Kowa VX-10α. 2361 by 1568 pixels — 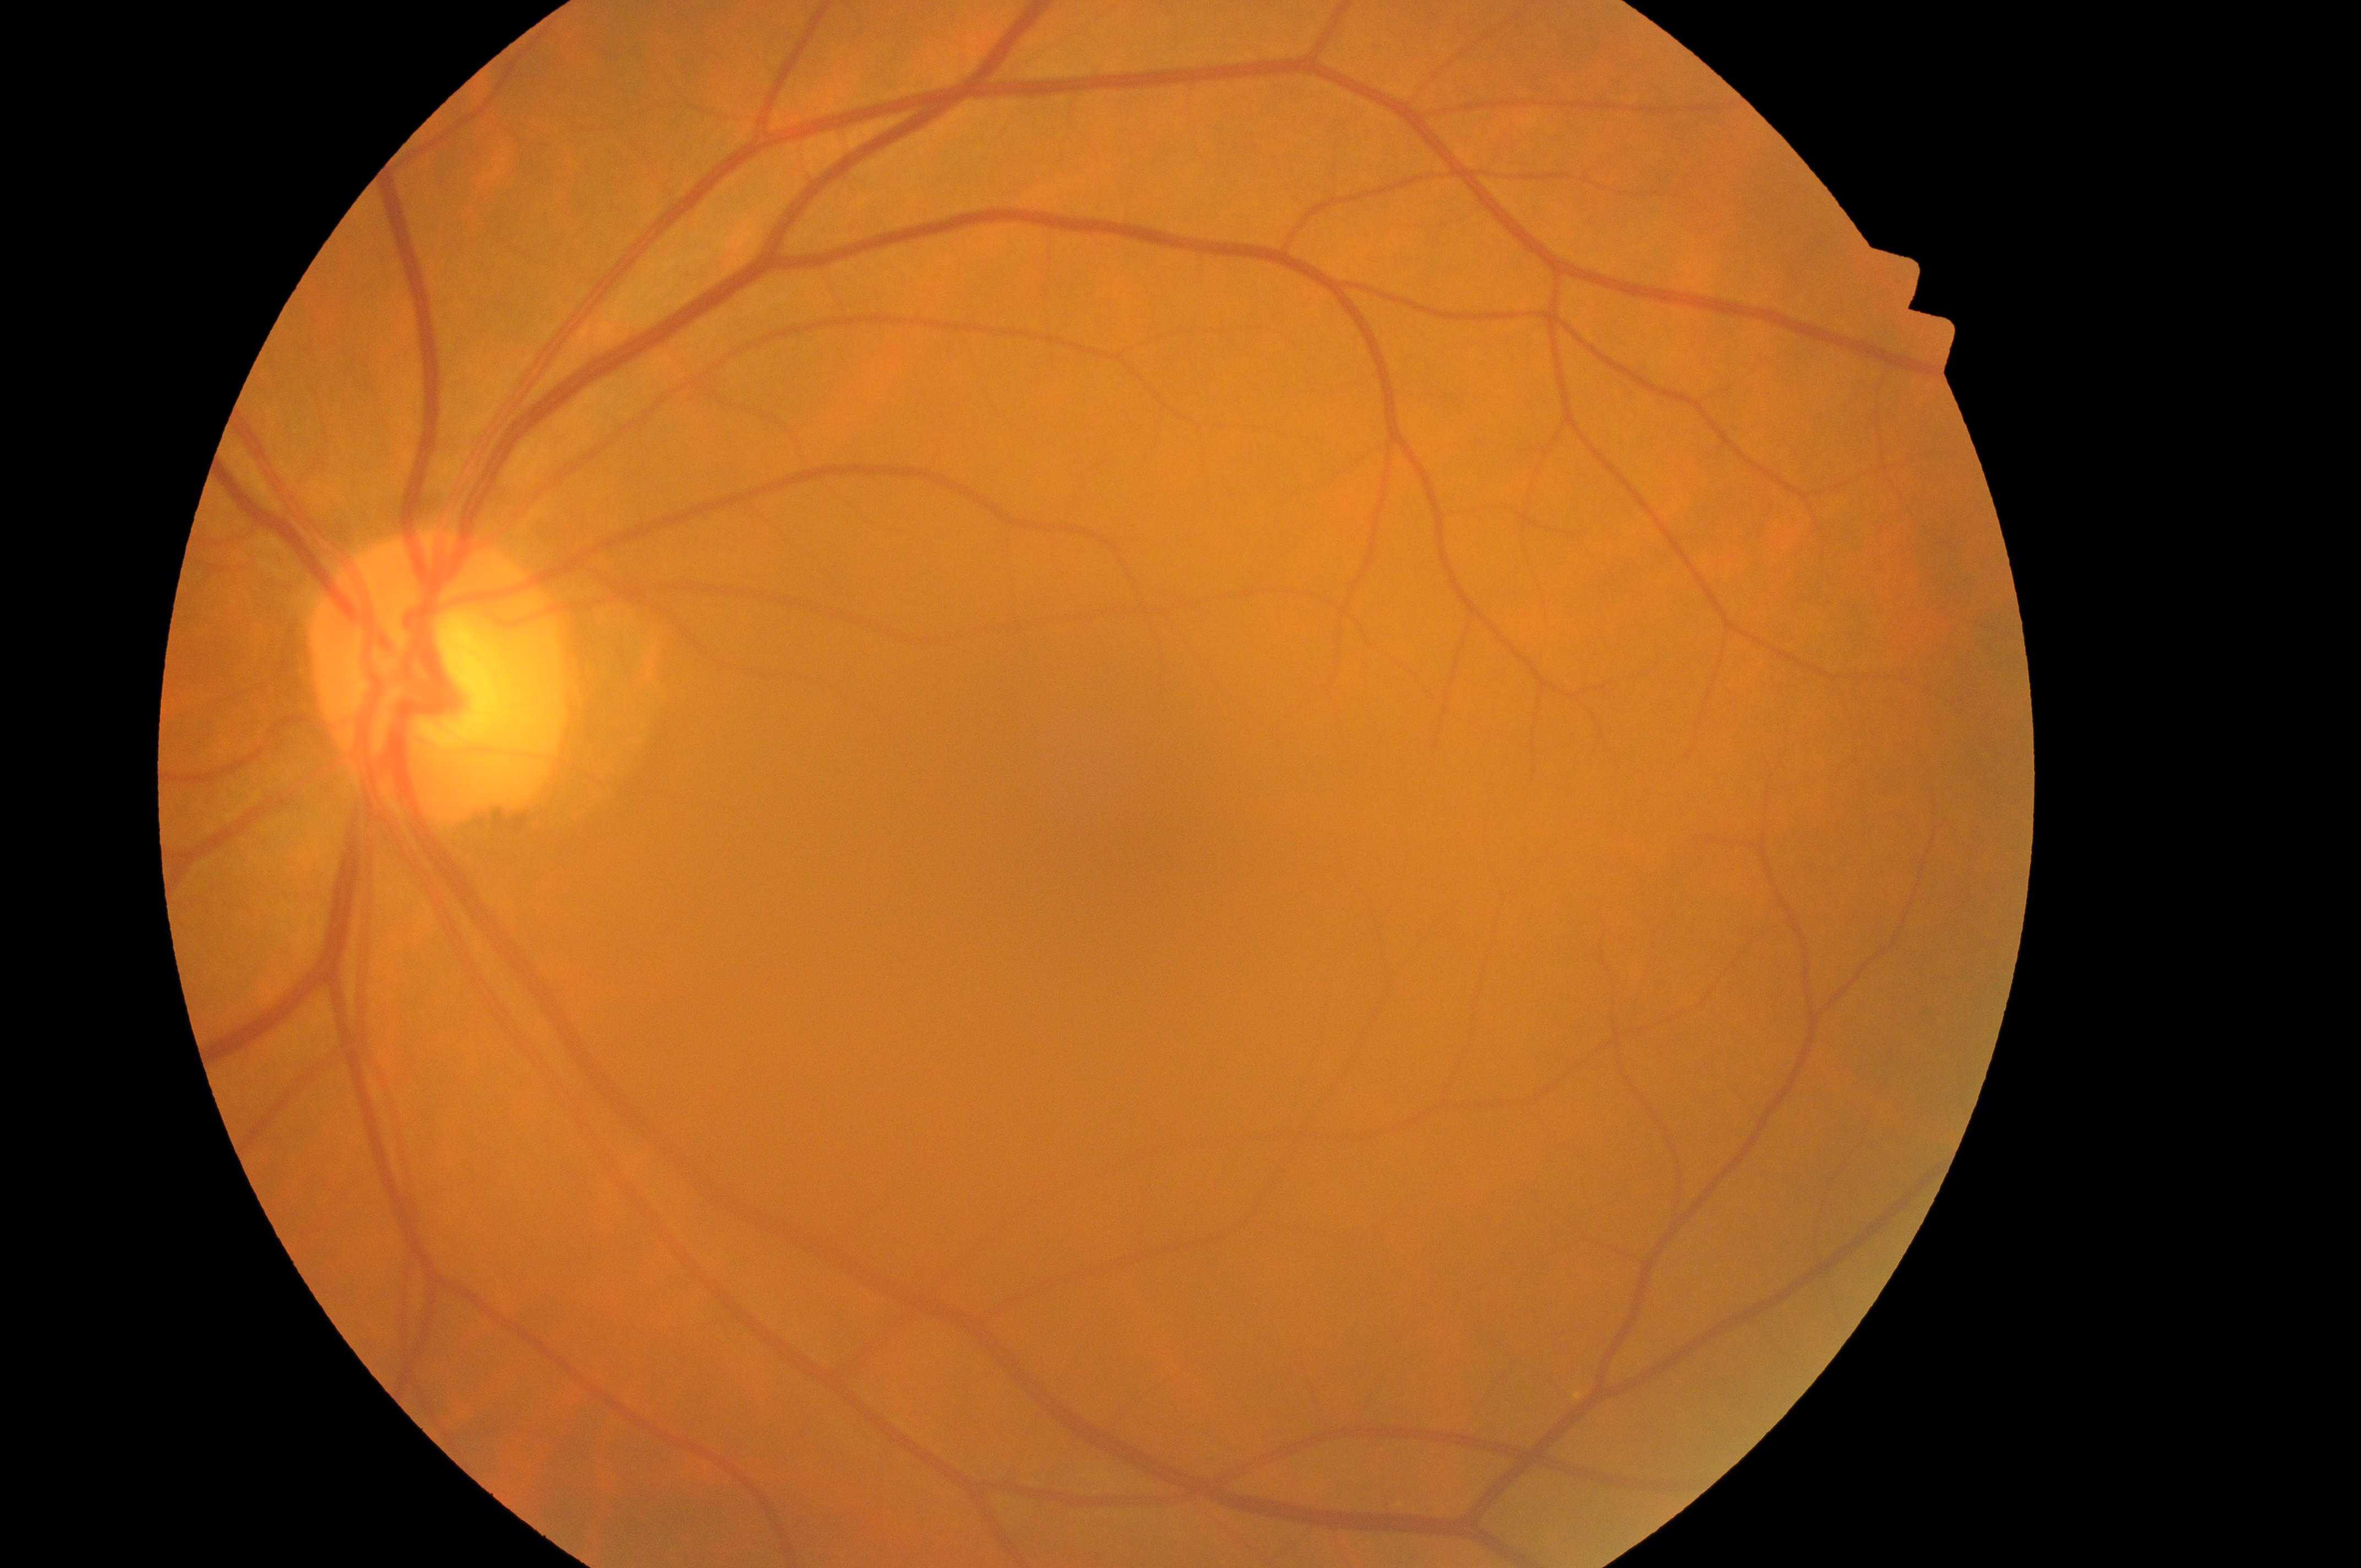 Diabetic retinopathy (DR): no apparent retinopathy (grade 0) — no visible signs of diabetic retinopathy.
Macula center located at (x=1107, y=793).
Eye: the left eye.
Diabetic macular edema (DME): no risk (grade 0) — no apparent hard exudates.
ONH located at (x=433, y=693).